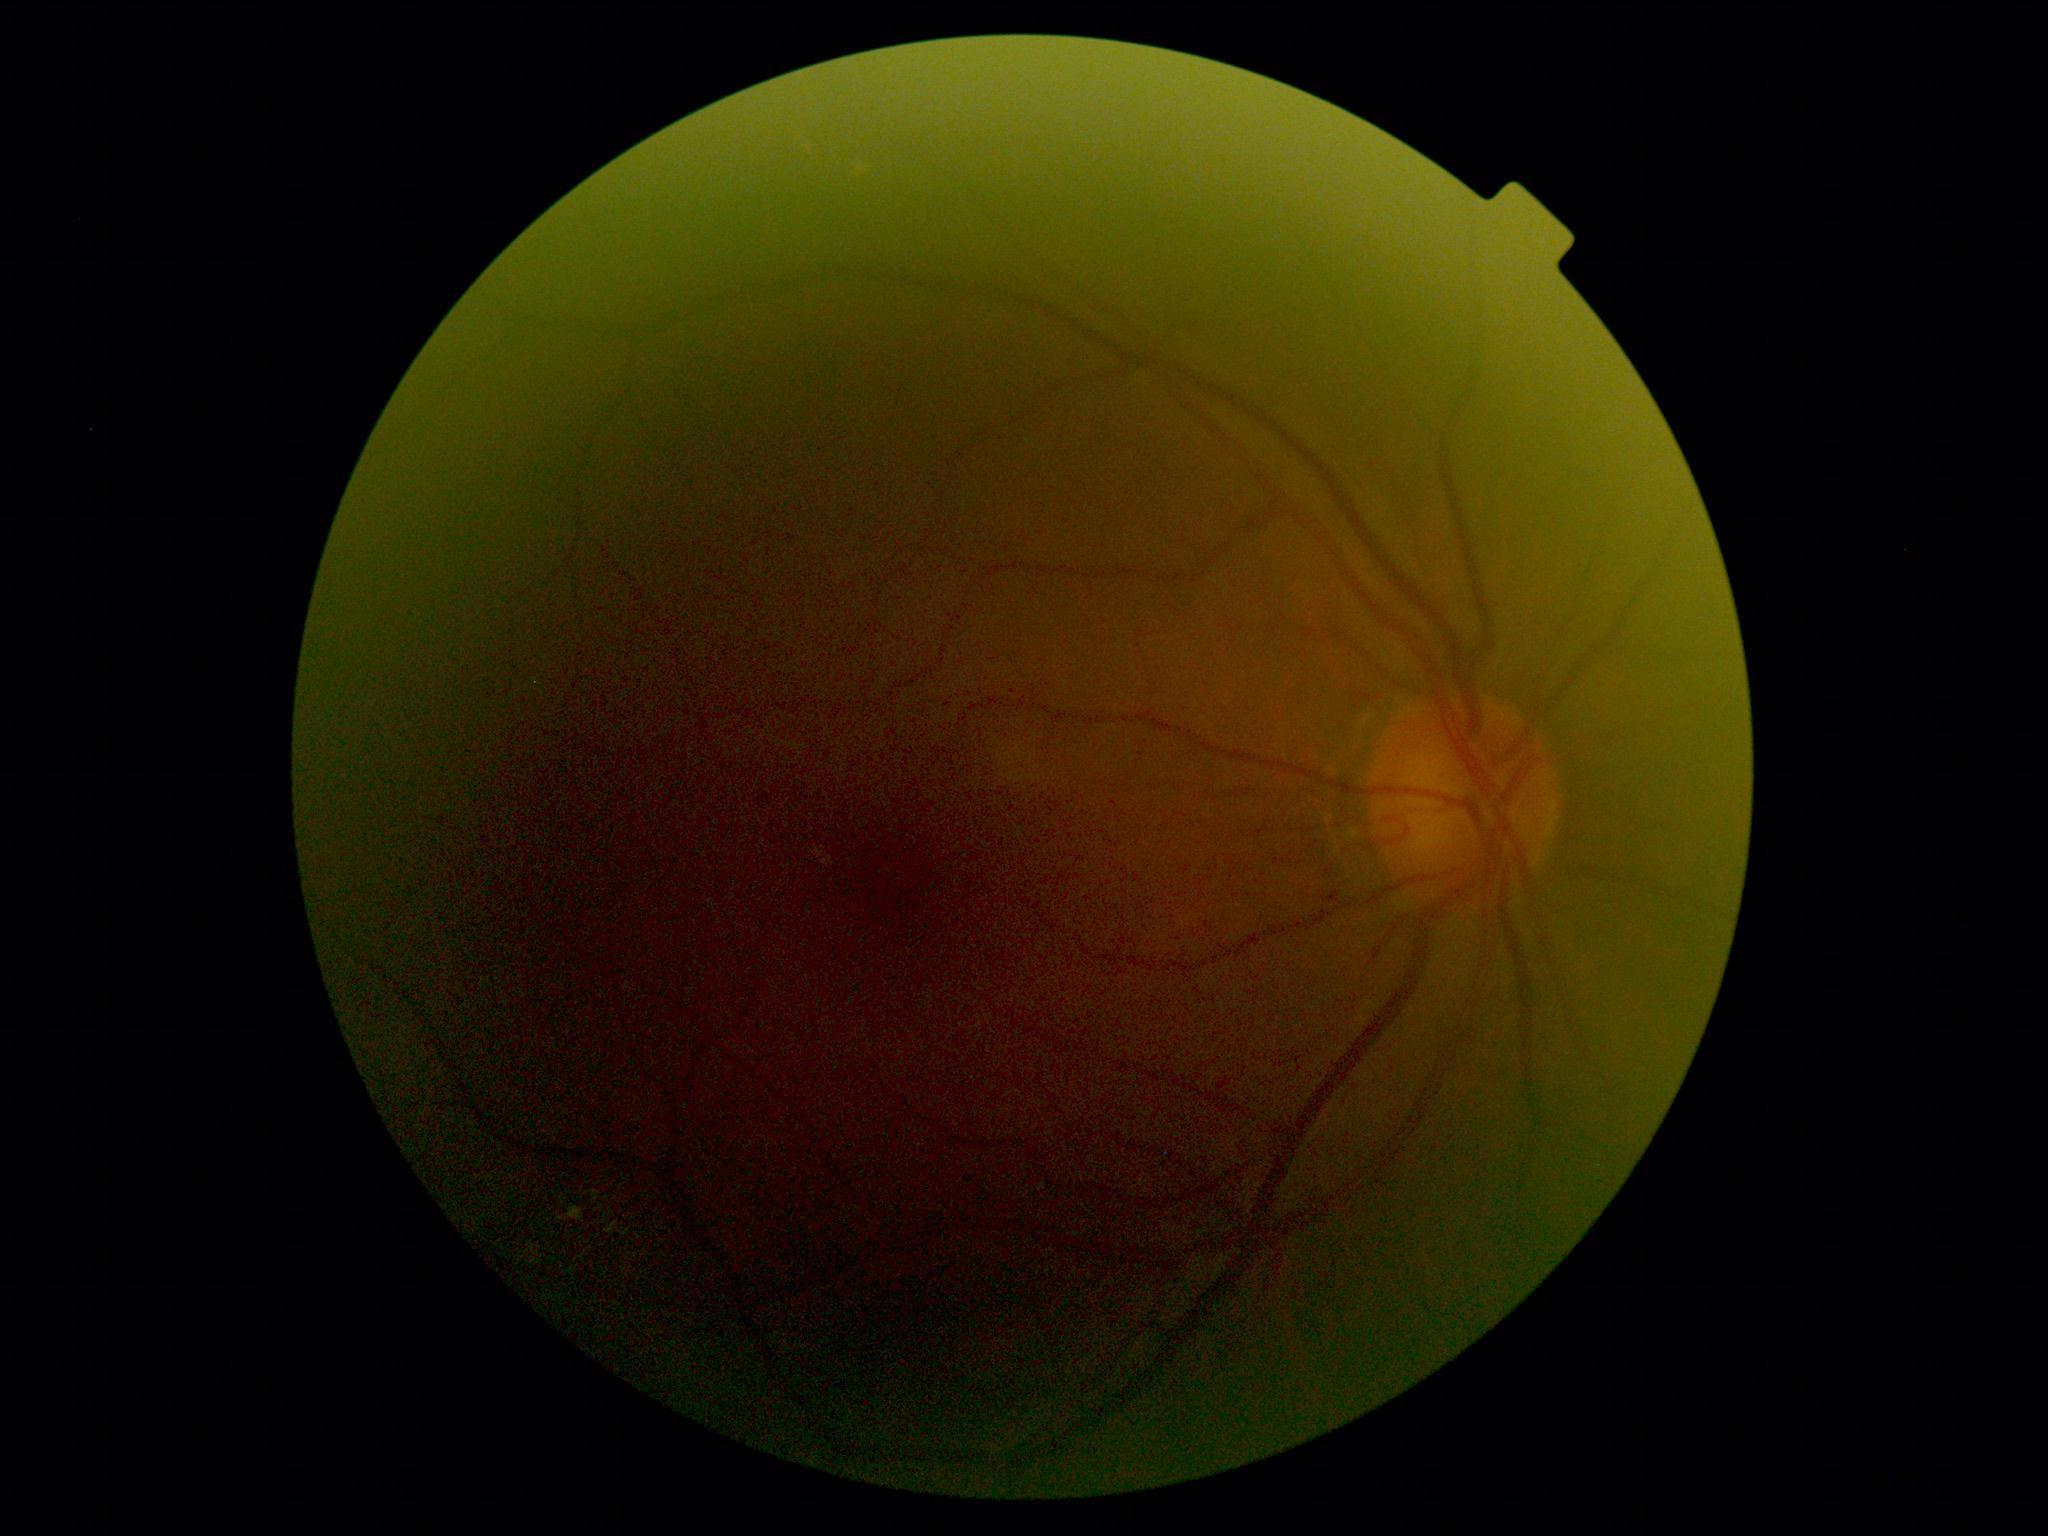 diabetic retinopathy (DR): moderate non-proliferative diabetic retinopathy (grade 2), DR class: non-proliferative diabetic retinopathy.